Infant wide-field fundus photograph
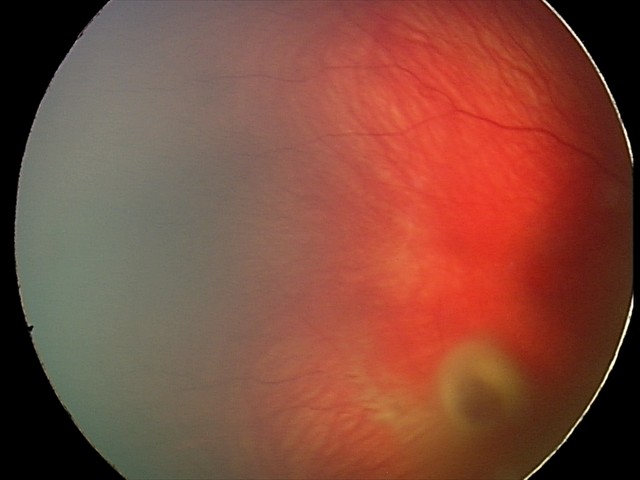 Impression = retinal hemorrhages.